1932 by 1932 pixels. Pupil-dilated.
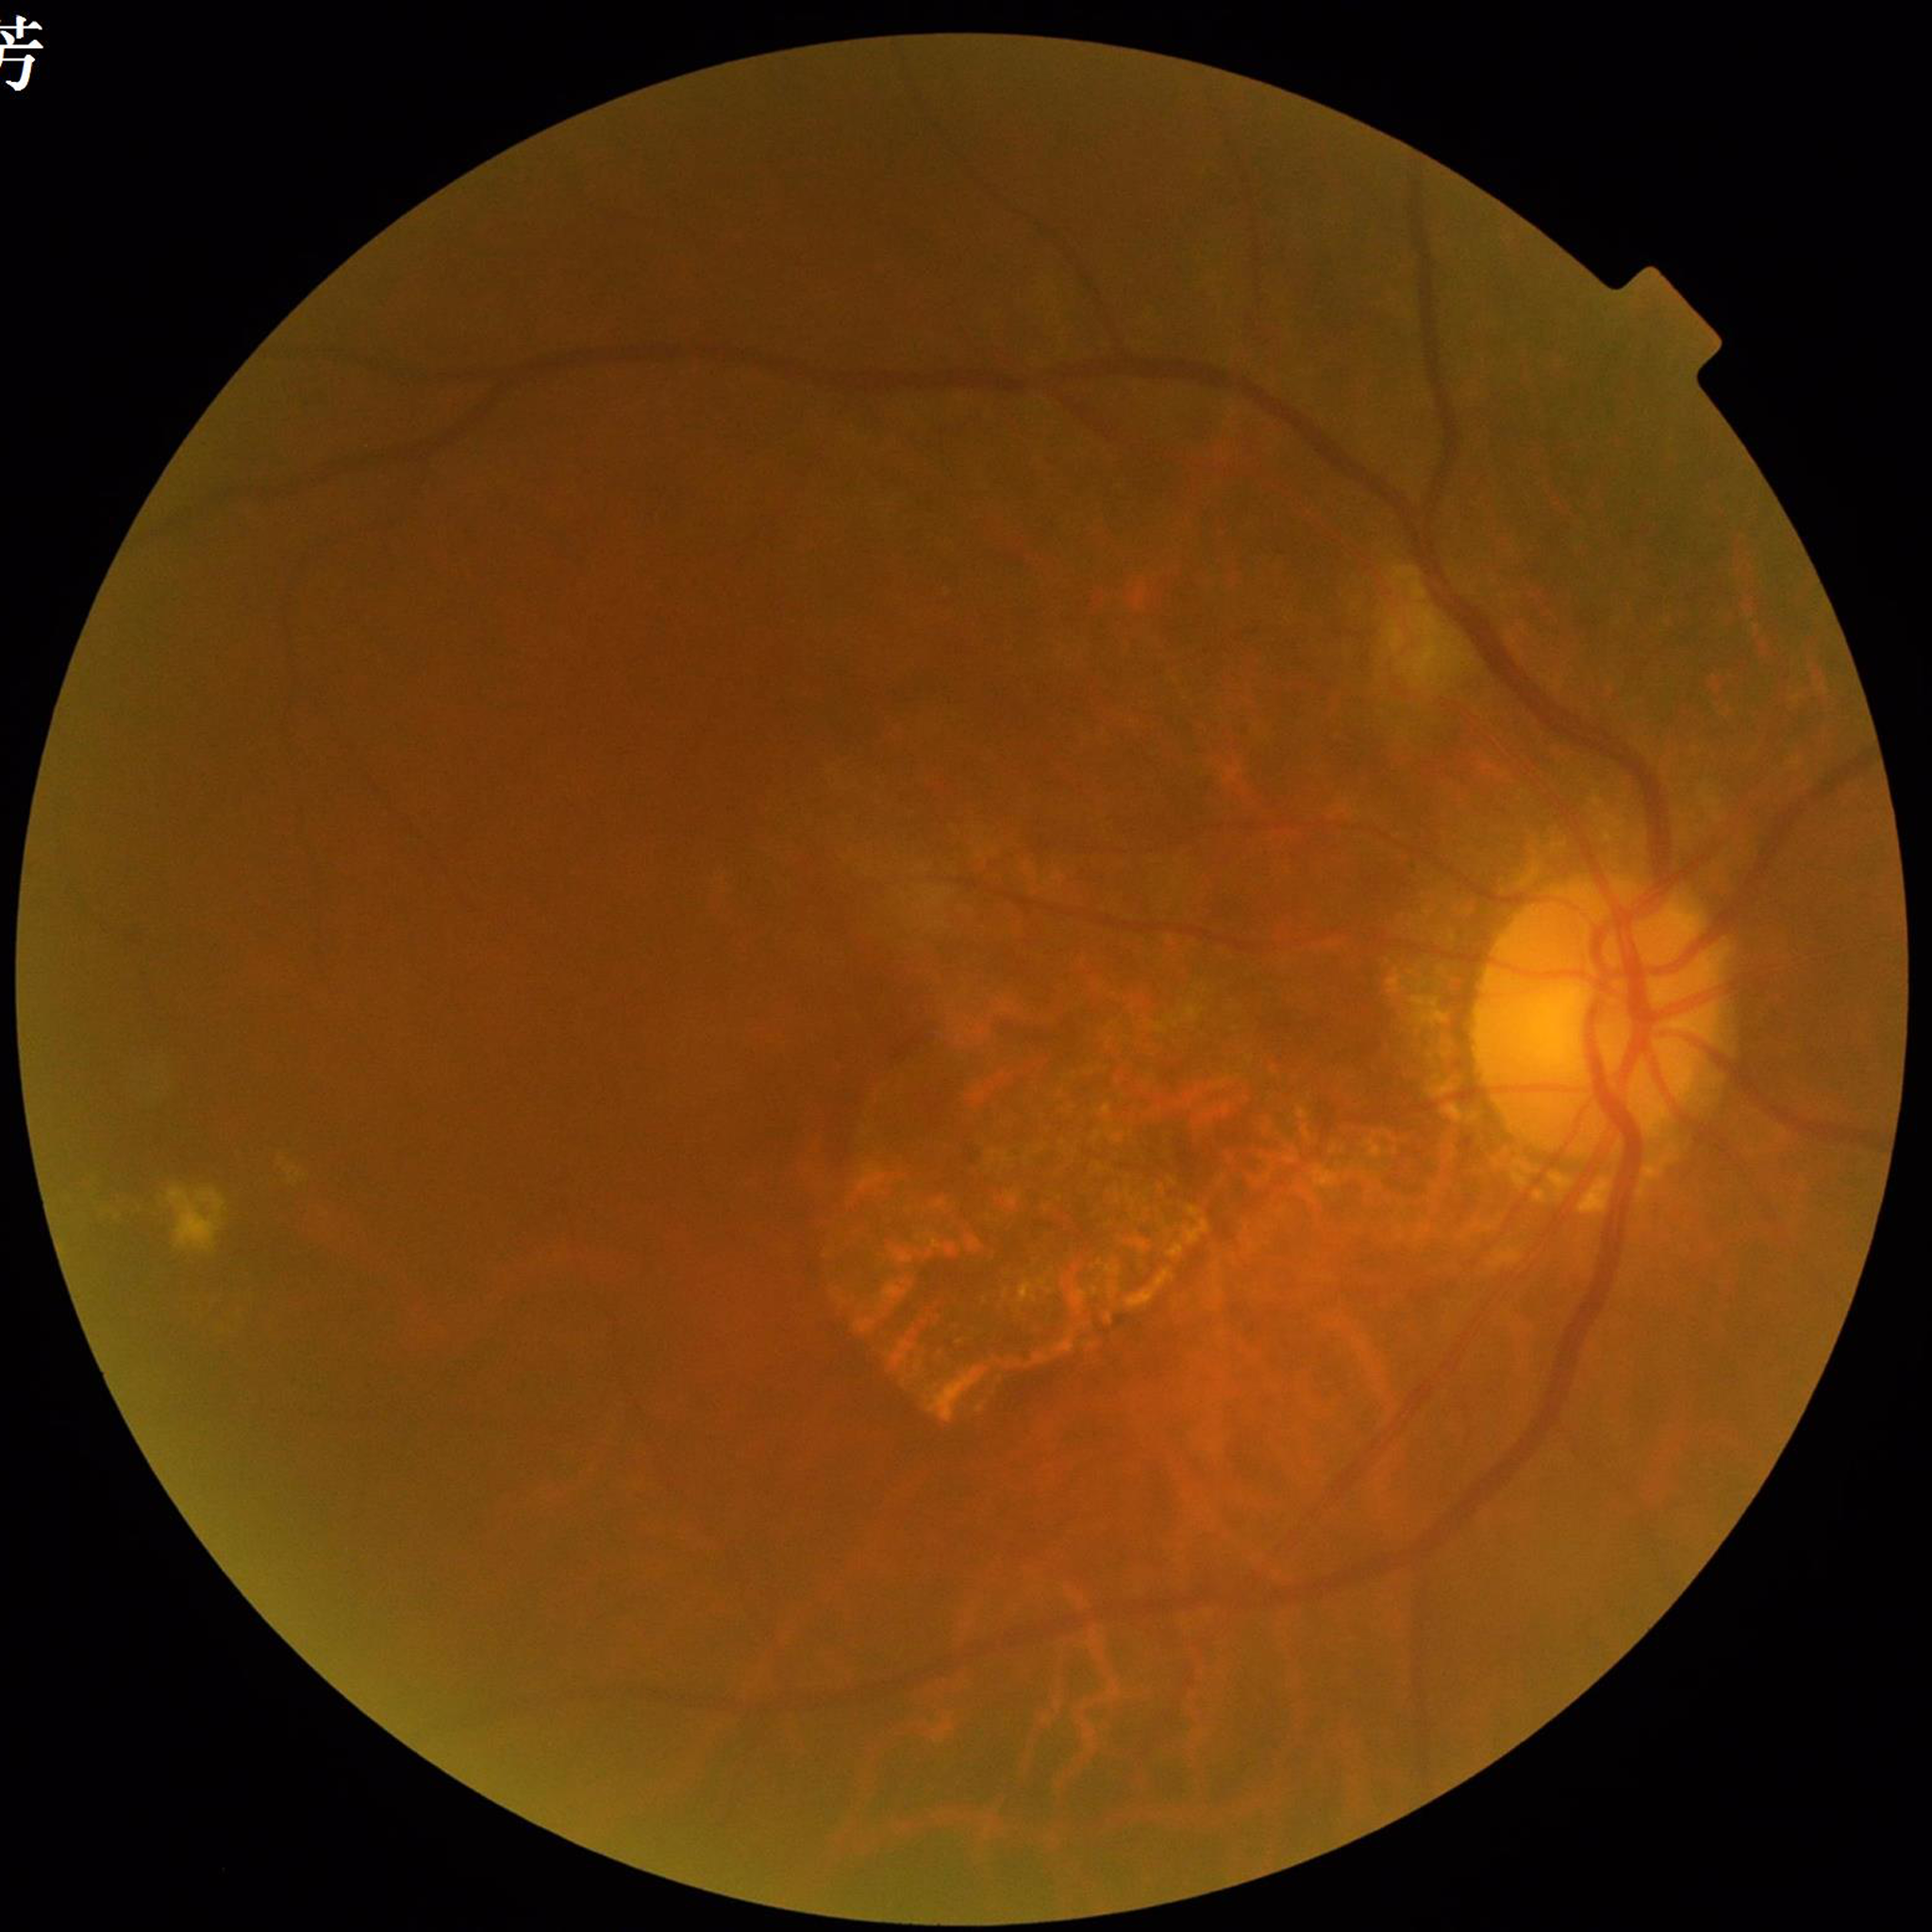
Clinical diagnosis = diabetic retinopathy
Quality = no concerns identified